Image size 1536x1152 · 45° FOV.
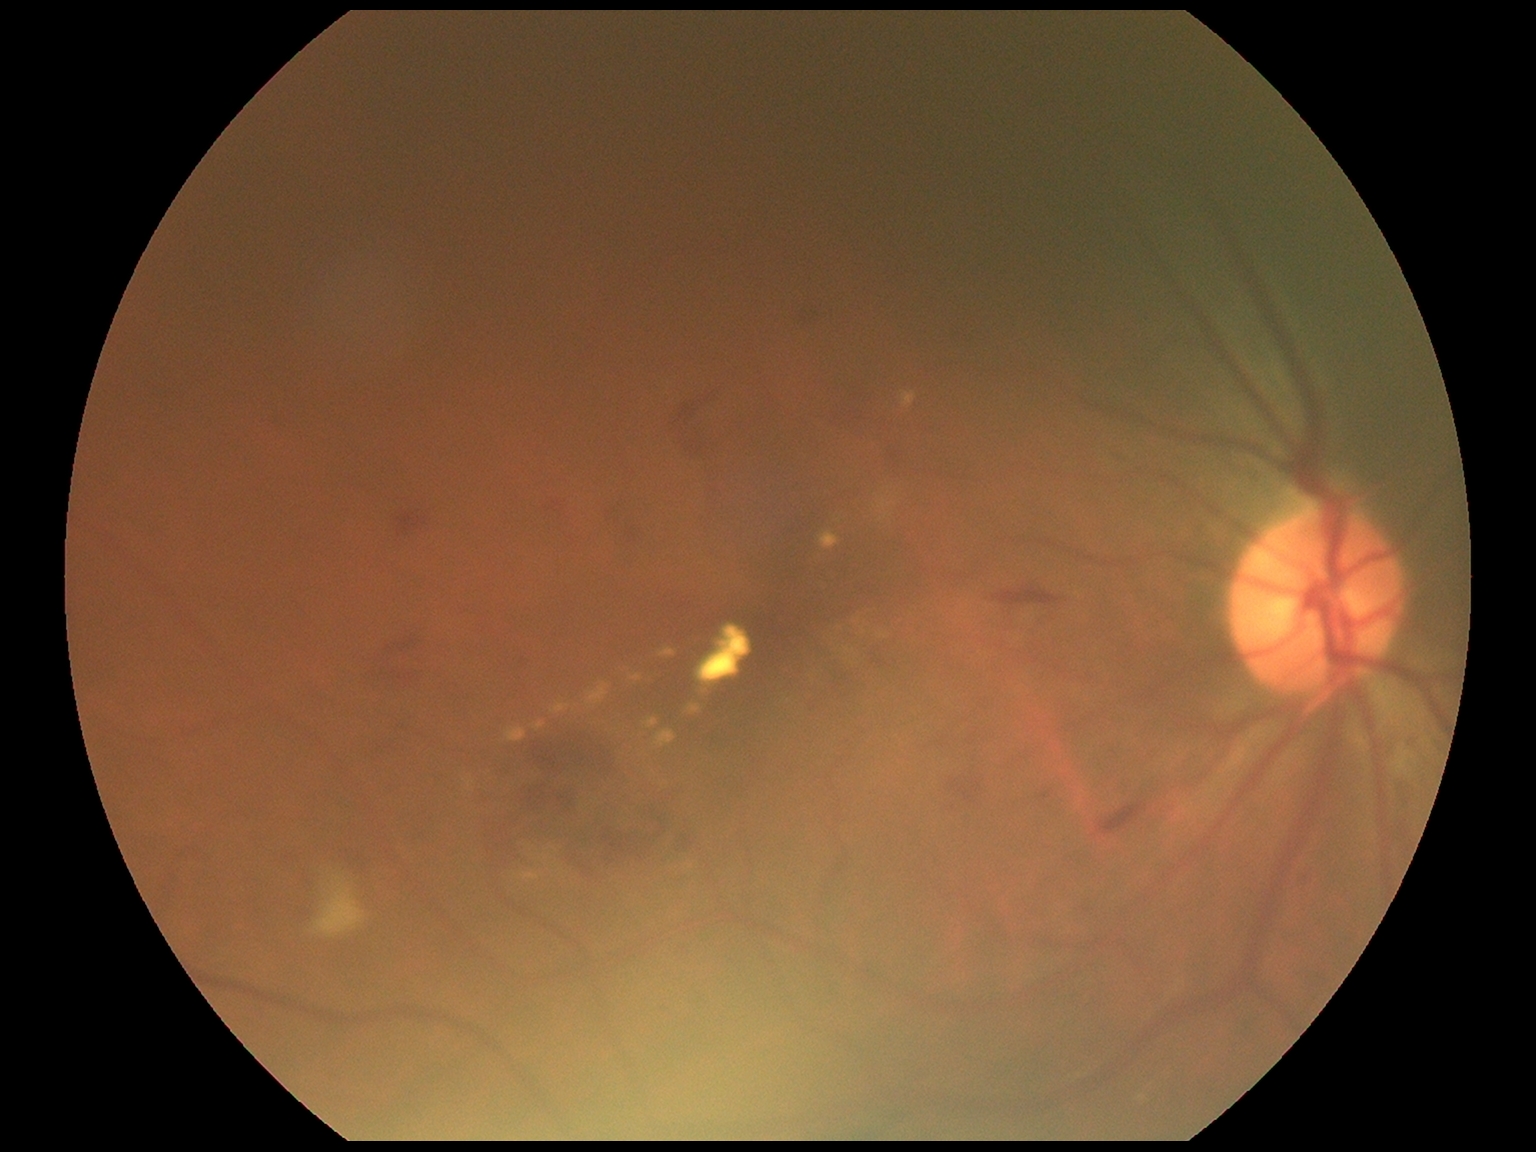
DR class = non-proliferative diabetic retinopathy, DR = grade 2 (moderate NPDR).